640x480. Wide-field fundus image from infant ROP screening — 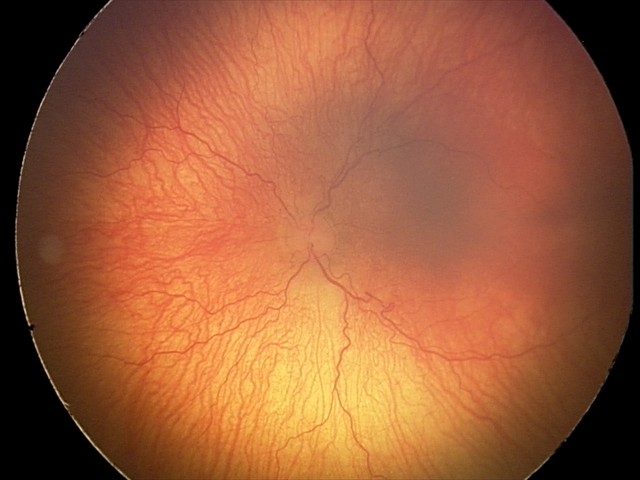
Plus disease present. Screening series with aggressive ROP (A-ROP).